Non-mydriatic fundus camera; CFP:
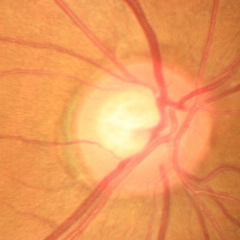
Demonstrates early-stage glaucoma.